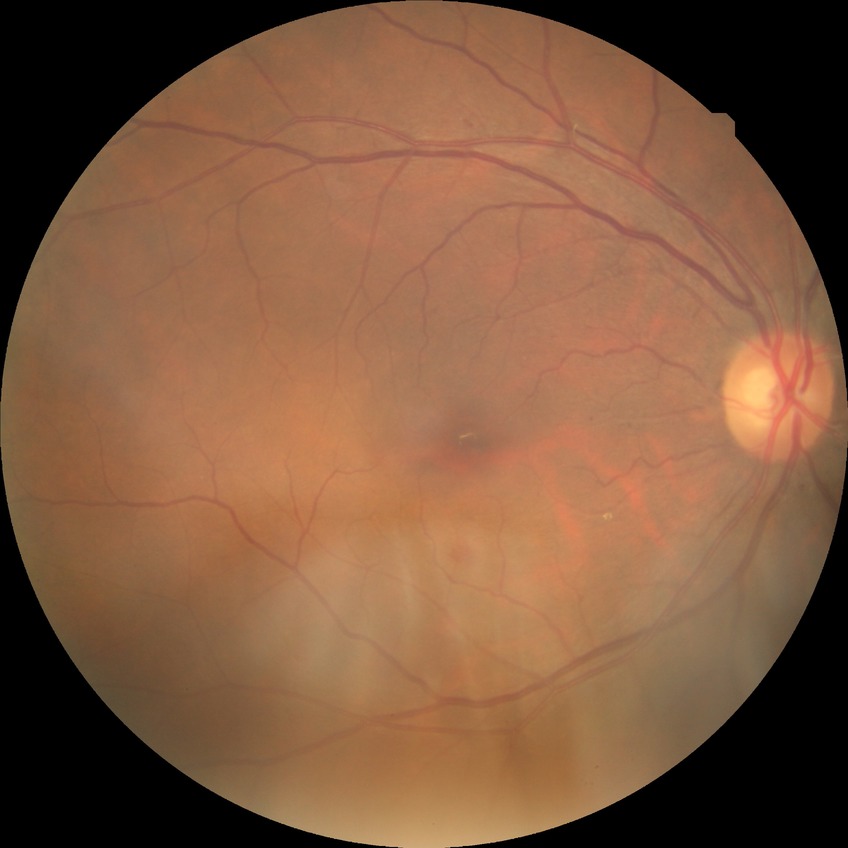
Davis grading = simple diabetic retinopathy.